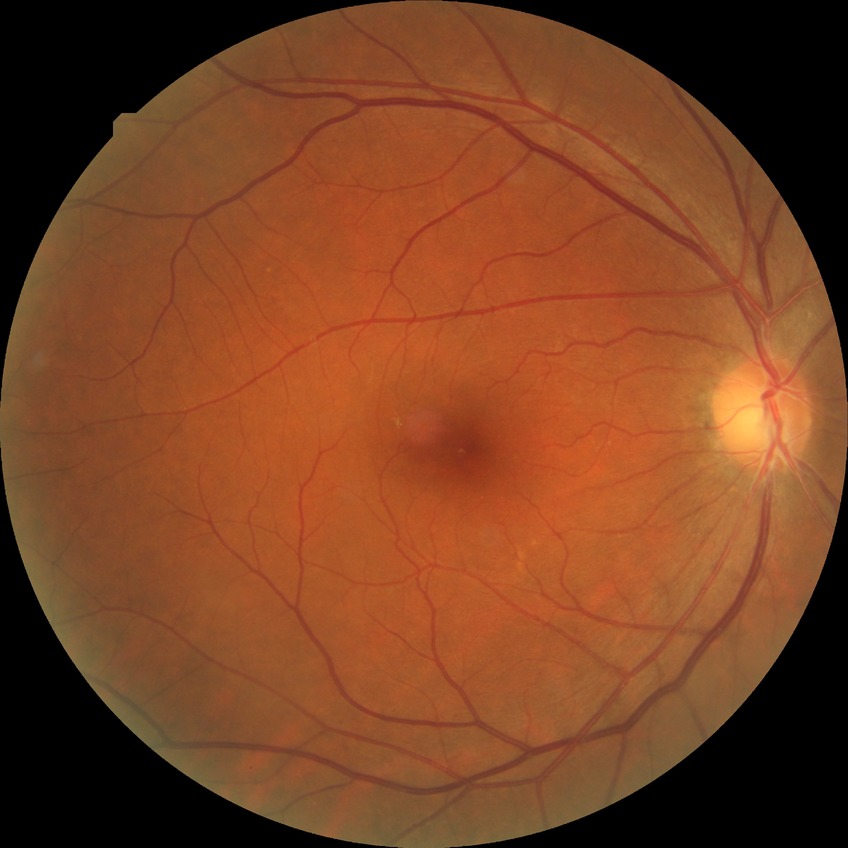
{"dr_impression": "no DR findings", "davis_grade": "NDR"}